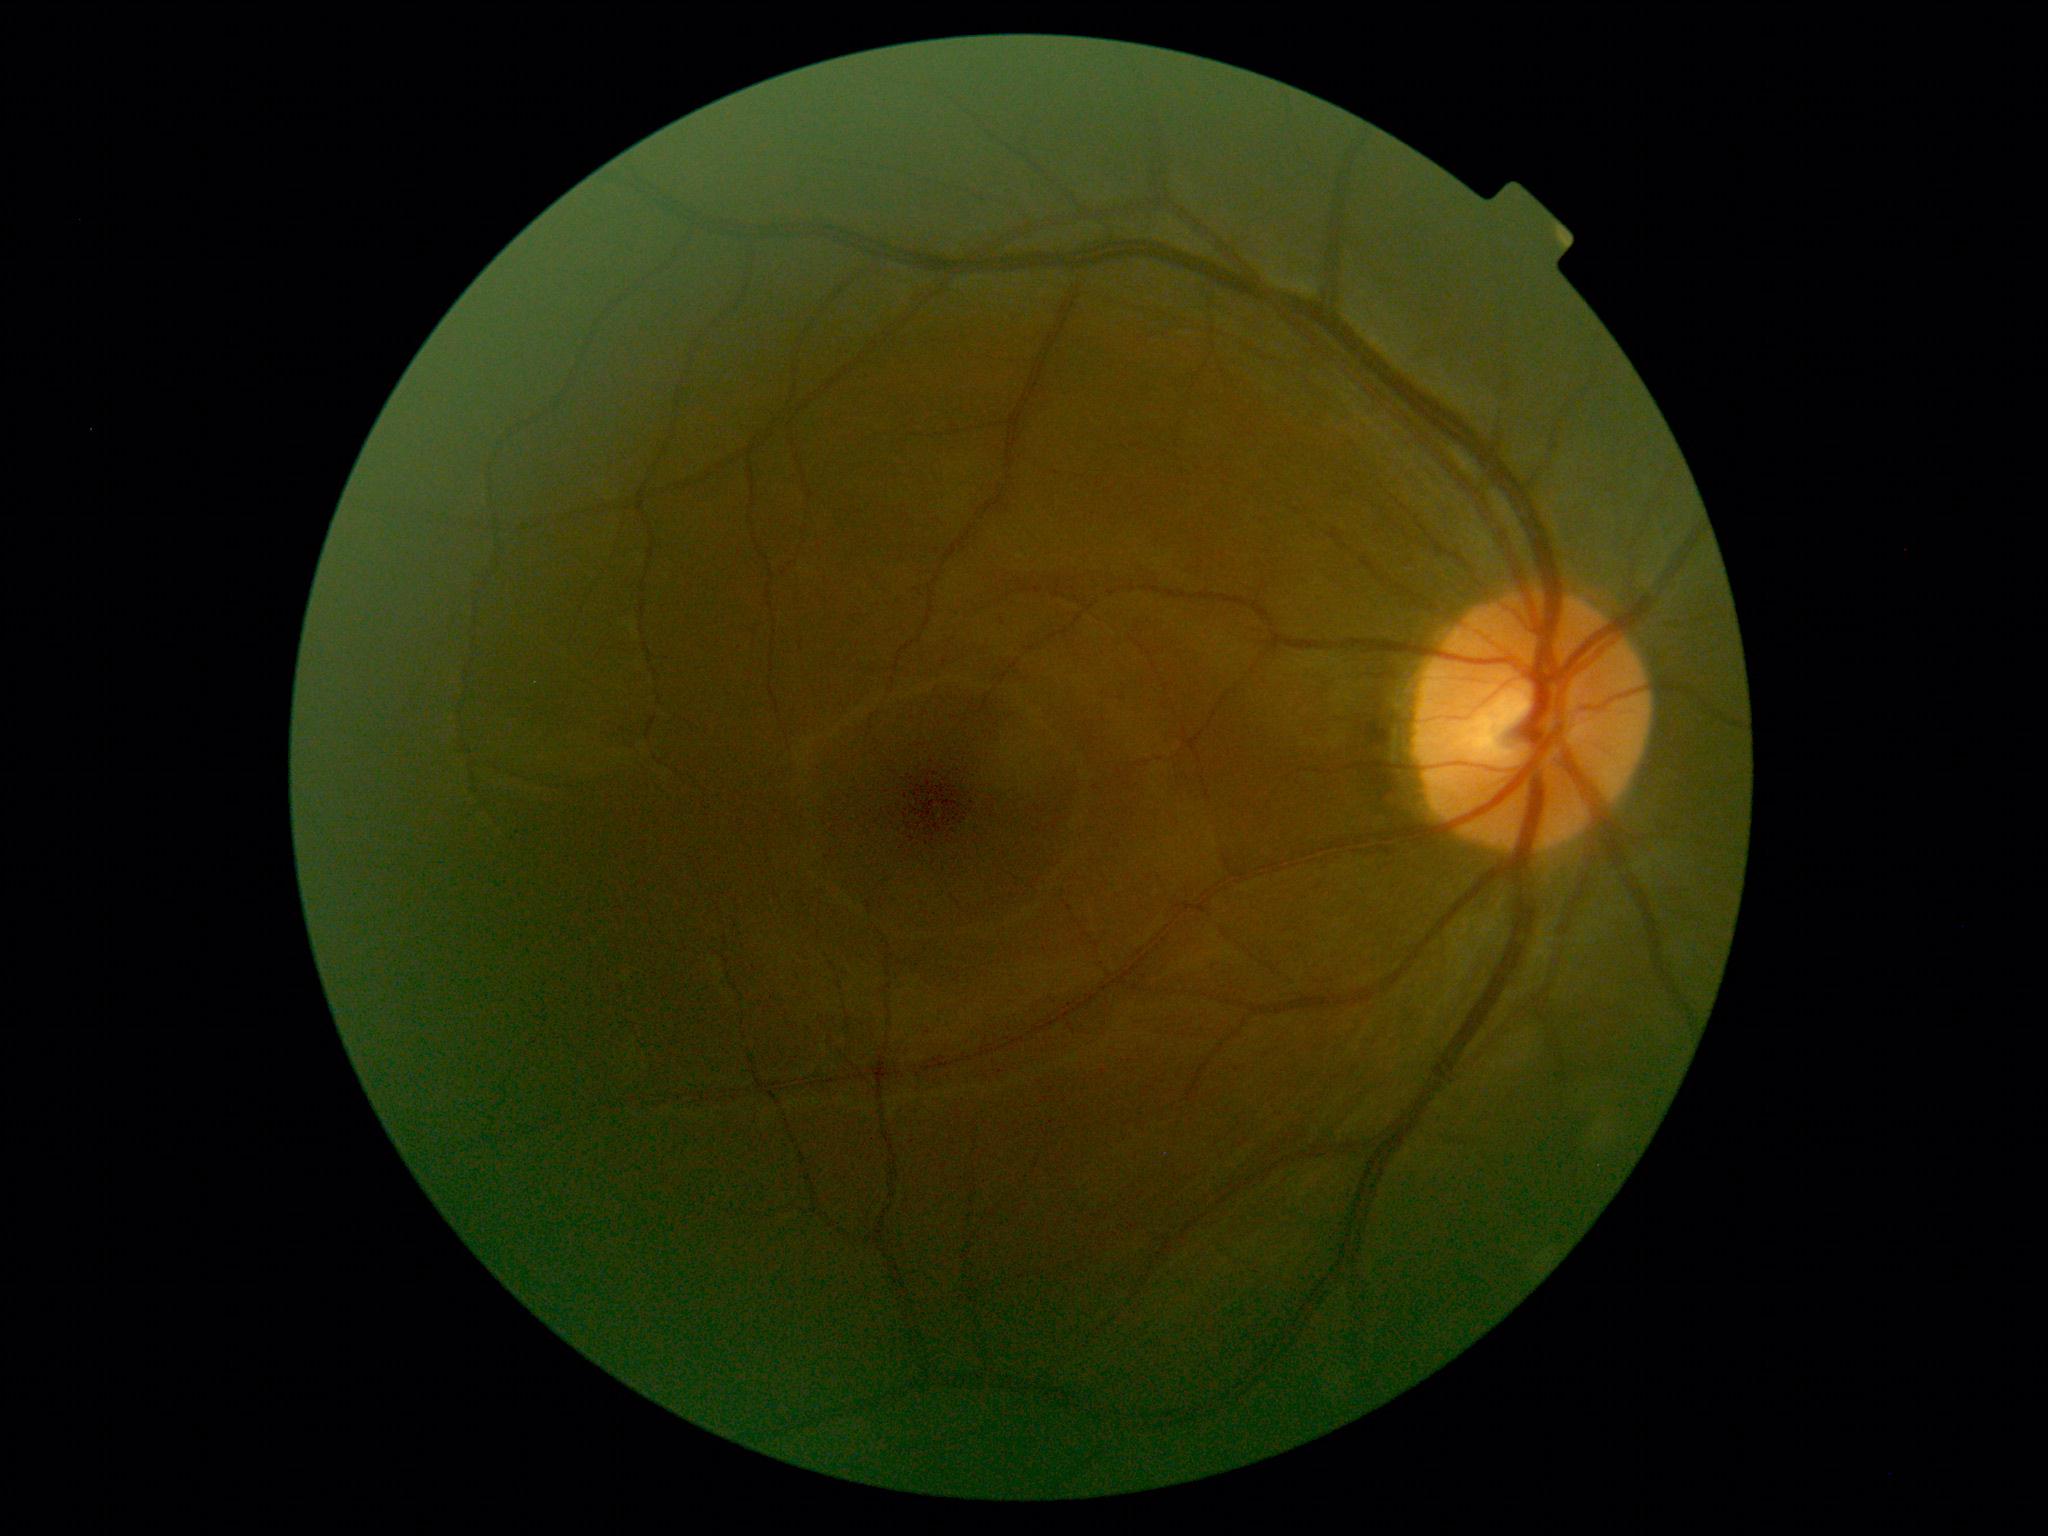
DR severity: no apparent diabetic retinopathy (grade 0).